Without pupil dilation; DR severity per modified Davis staging; 45° FOV; 848 by 848 pixels — 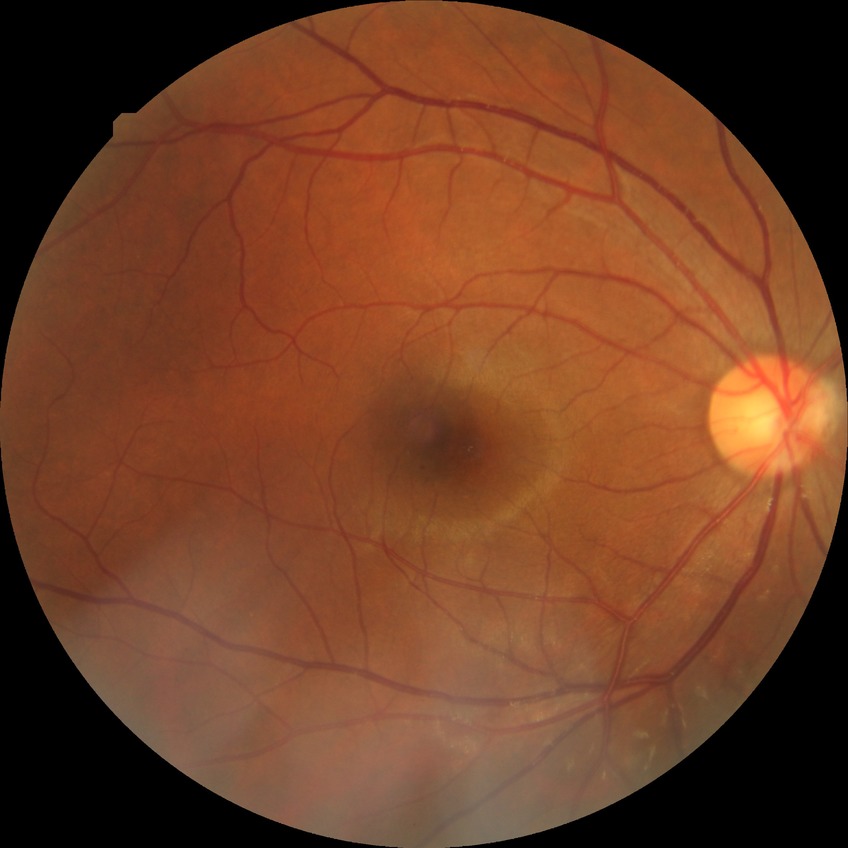
- diabetic retinopathy (DR): simple diabetic retinopathy (SDR)